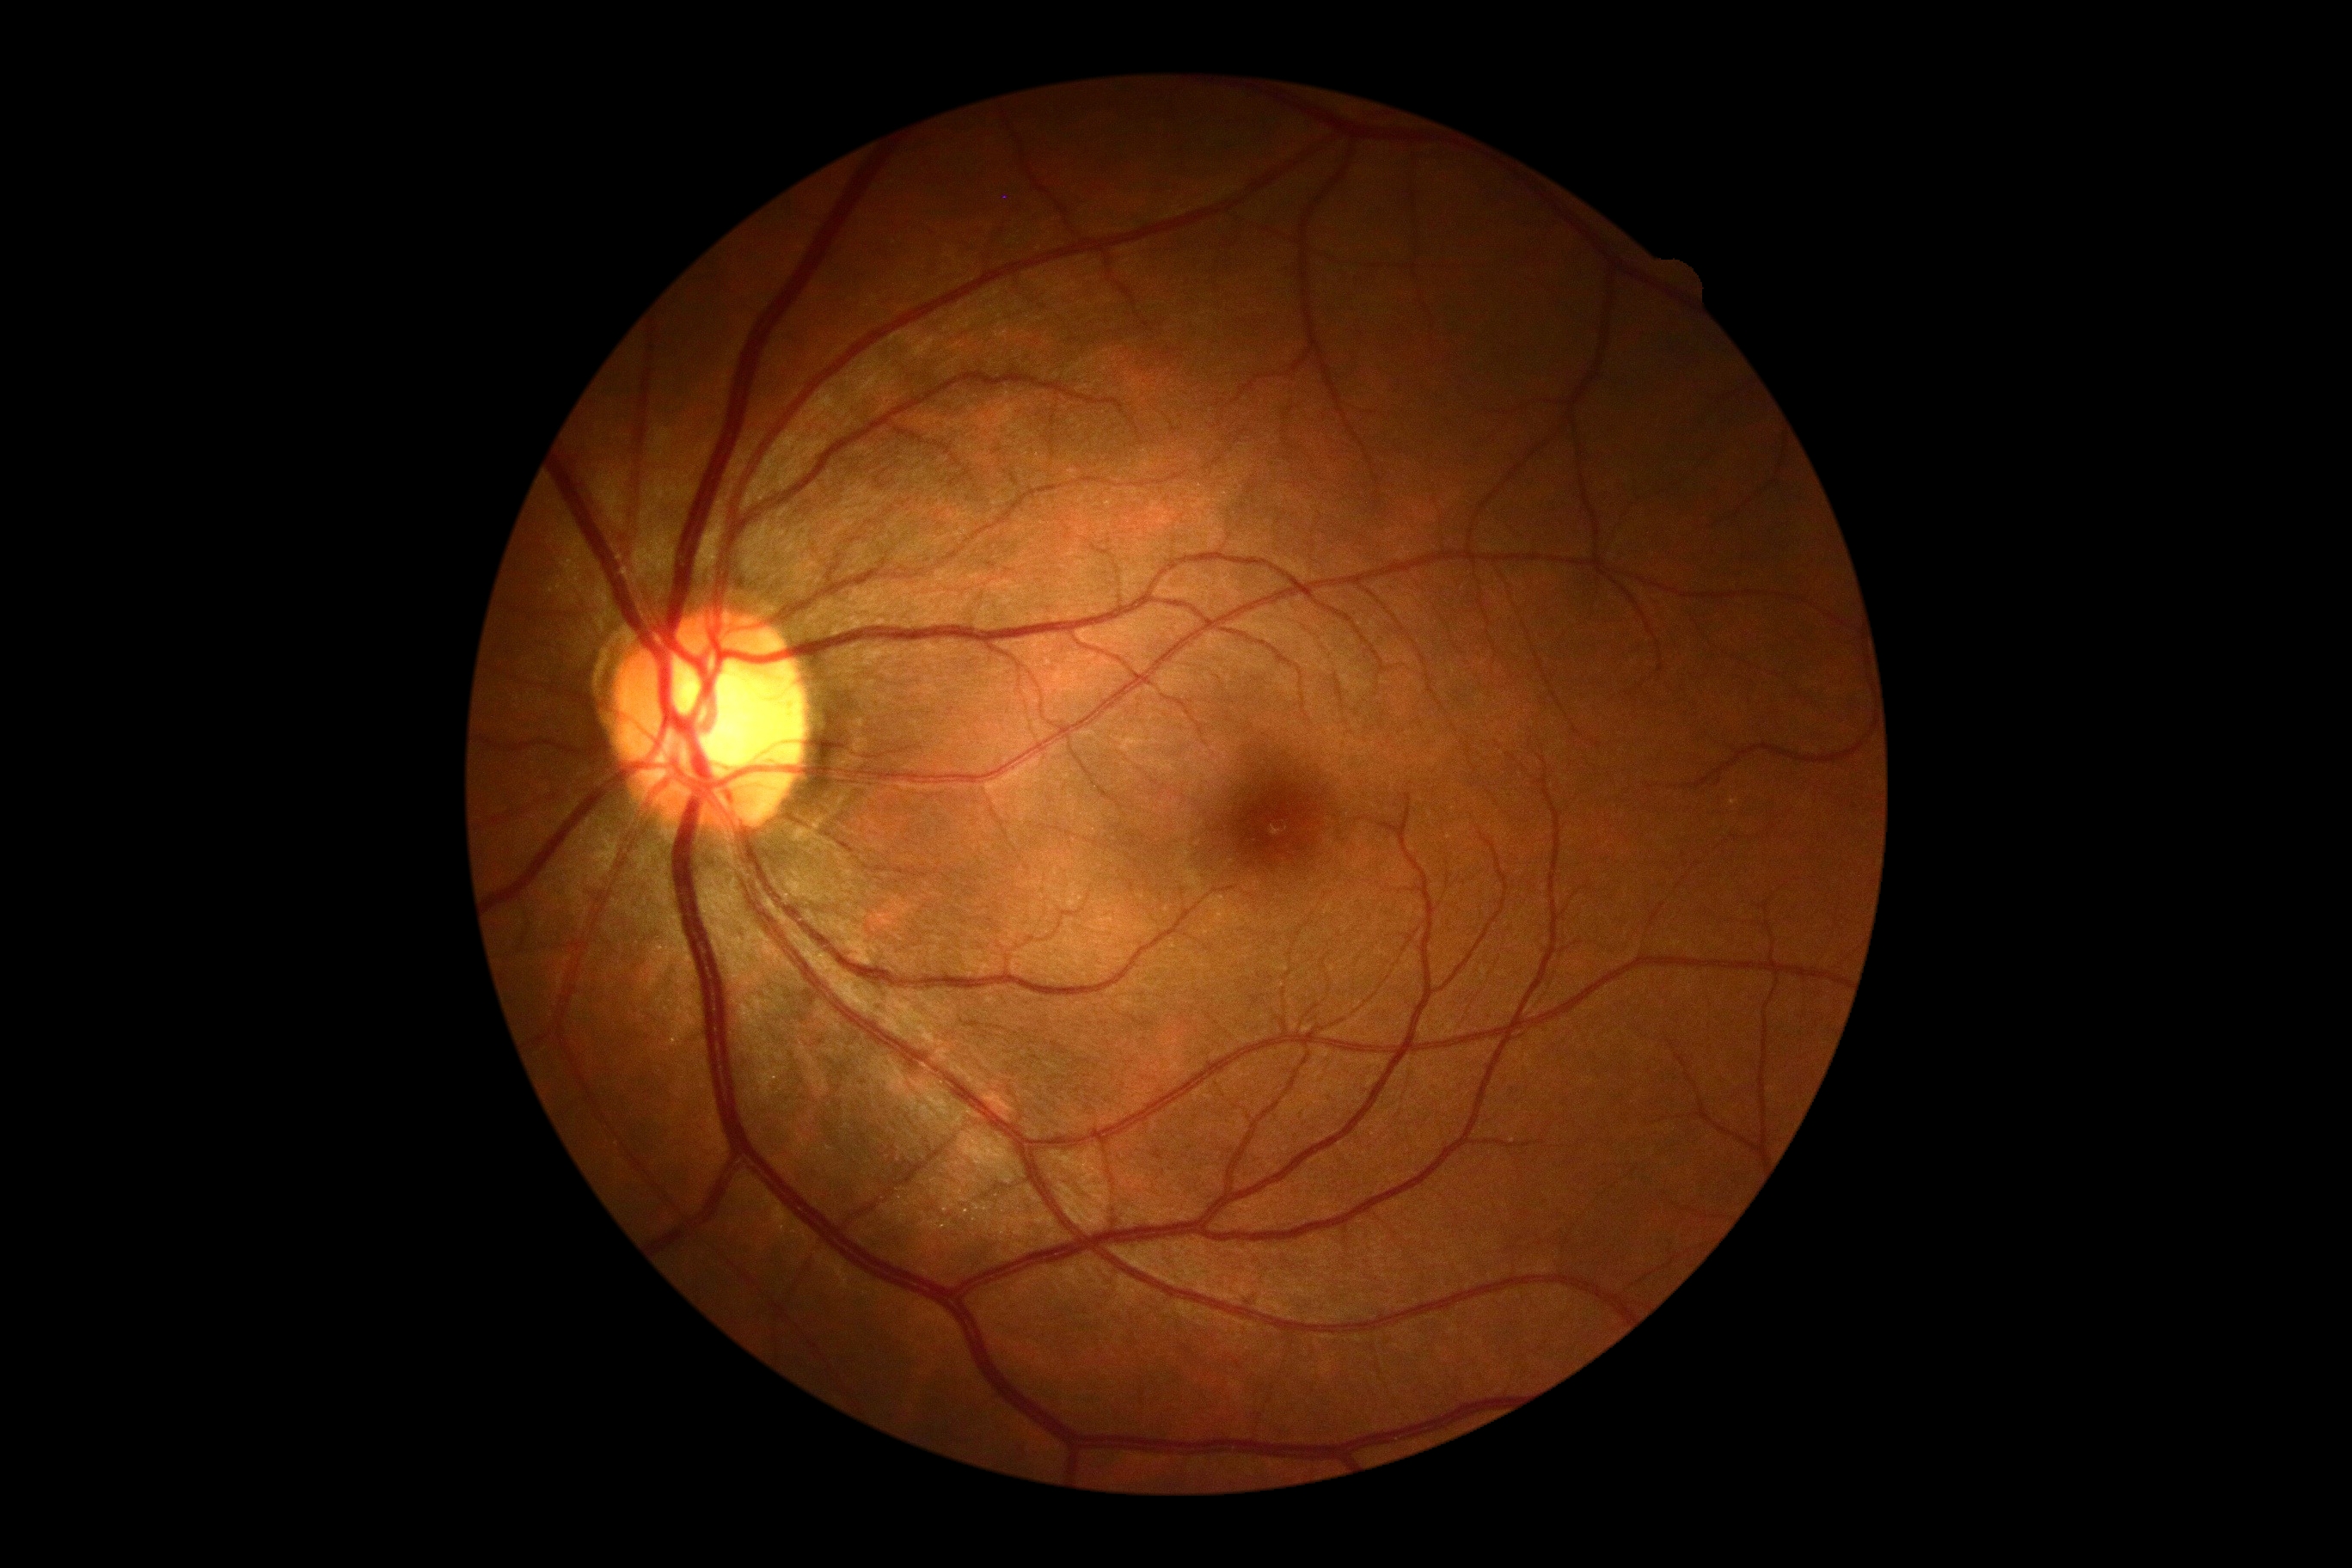
DR stage is no apparent diabetic retinopathy (grade 0). No apparent diabetic retinopathy.